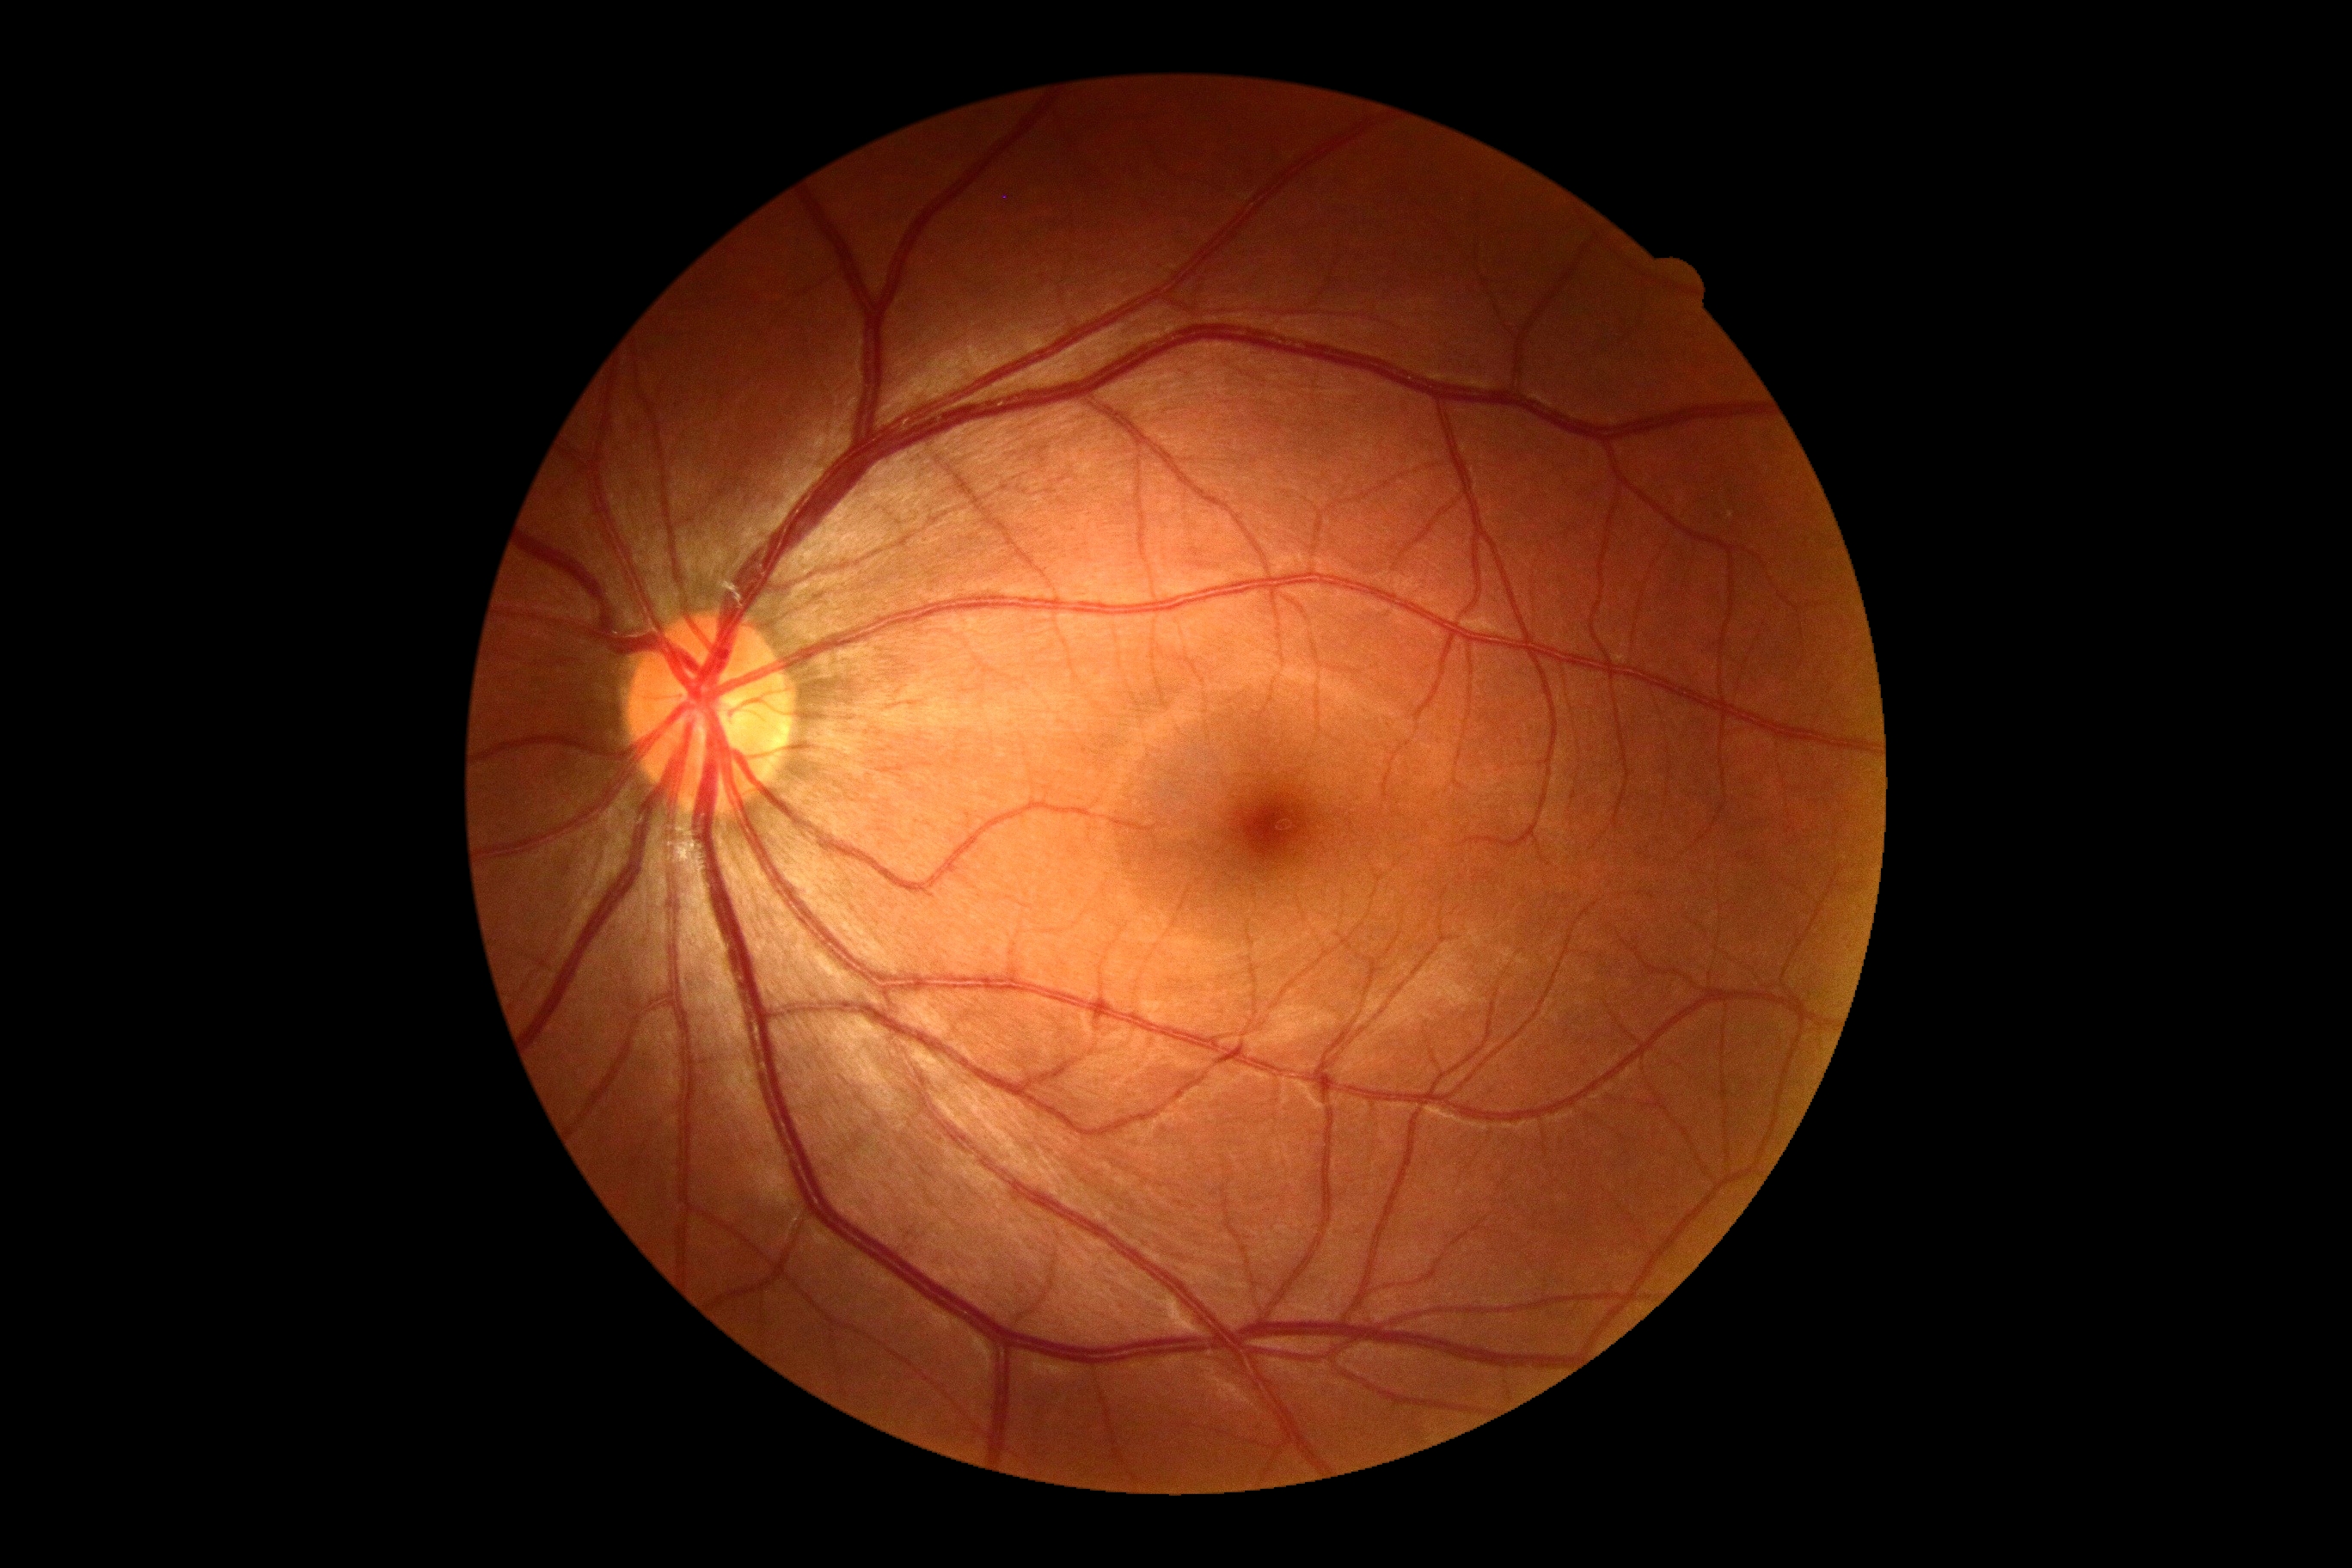
DR impression=no apparent DR, diabetic retinopathy (DR)=no apparent retinopathy (grade 0).